Image size 848x848 · posterior pole photograph.
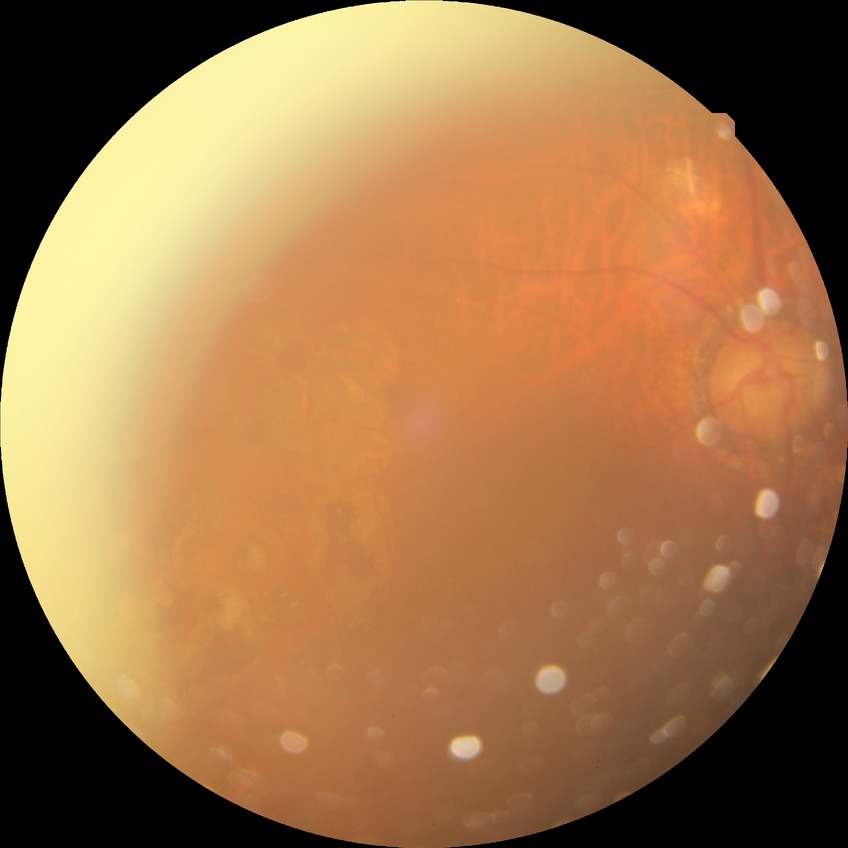
Diabetic retinopathy (DR): proliferative diabetic retinopathy (PDR).